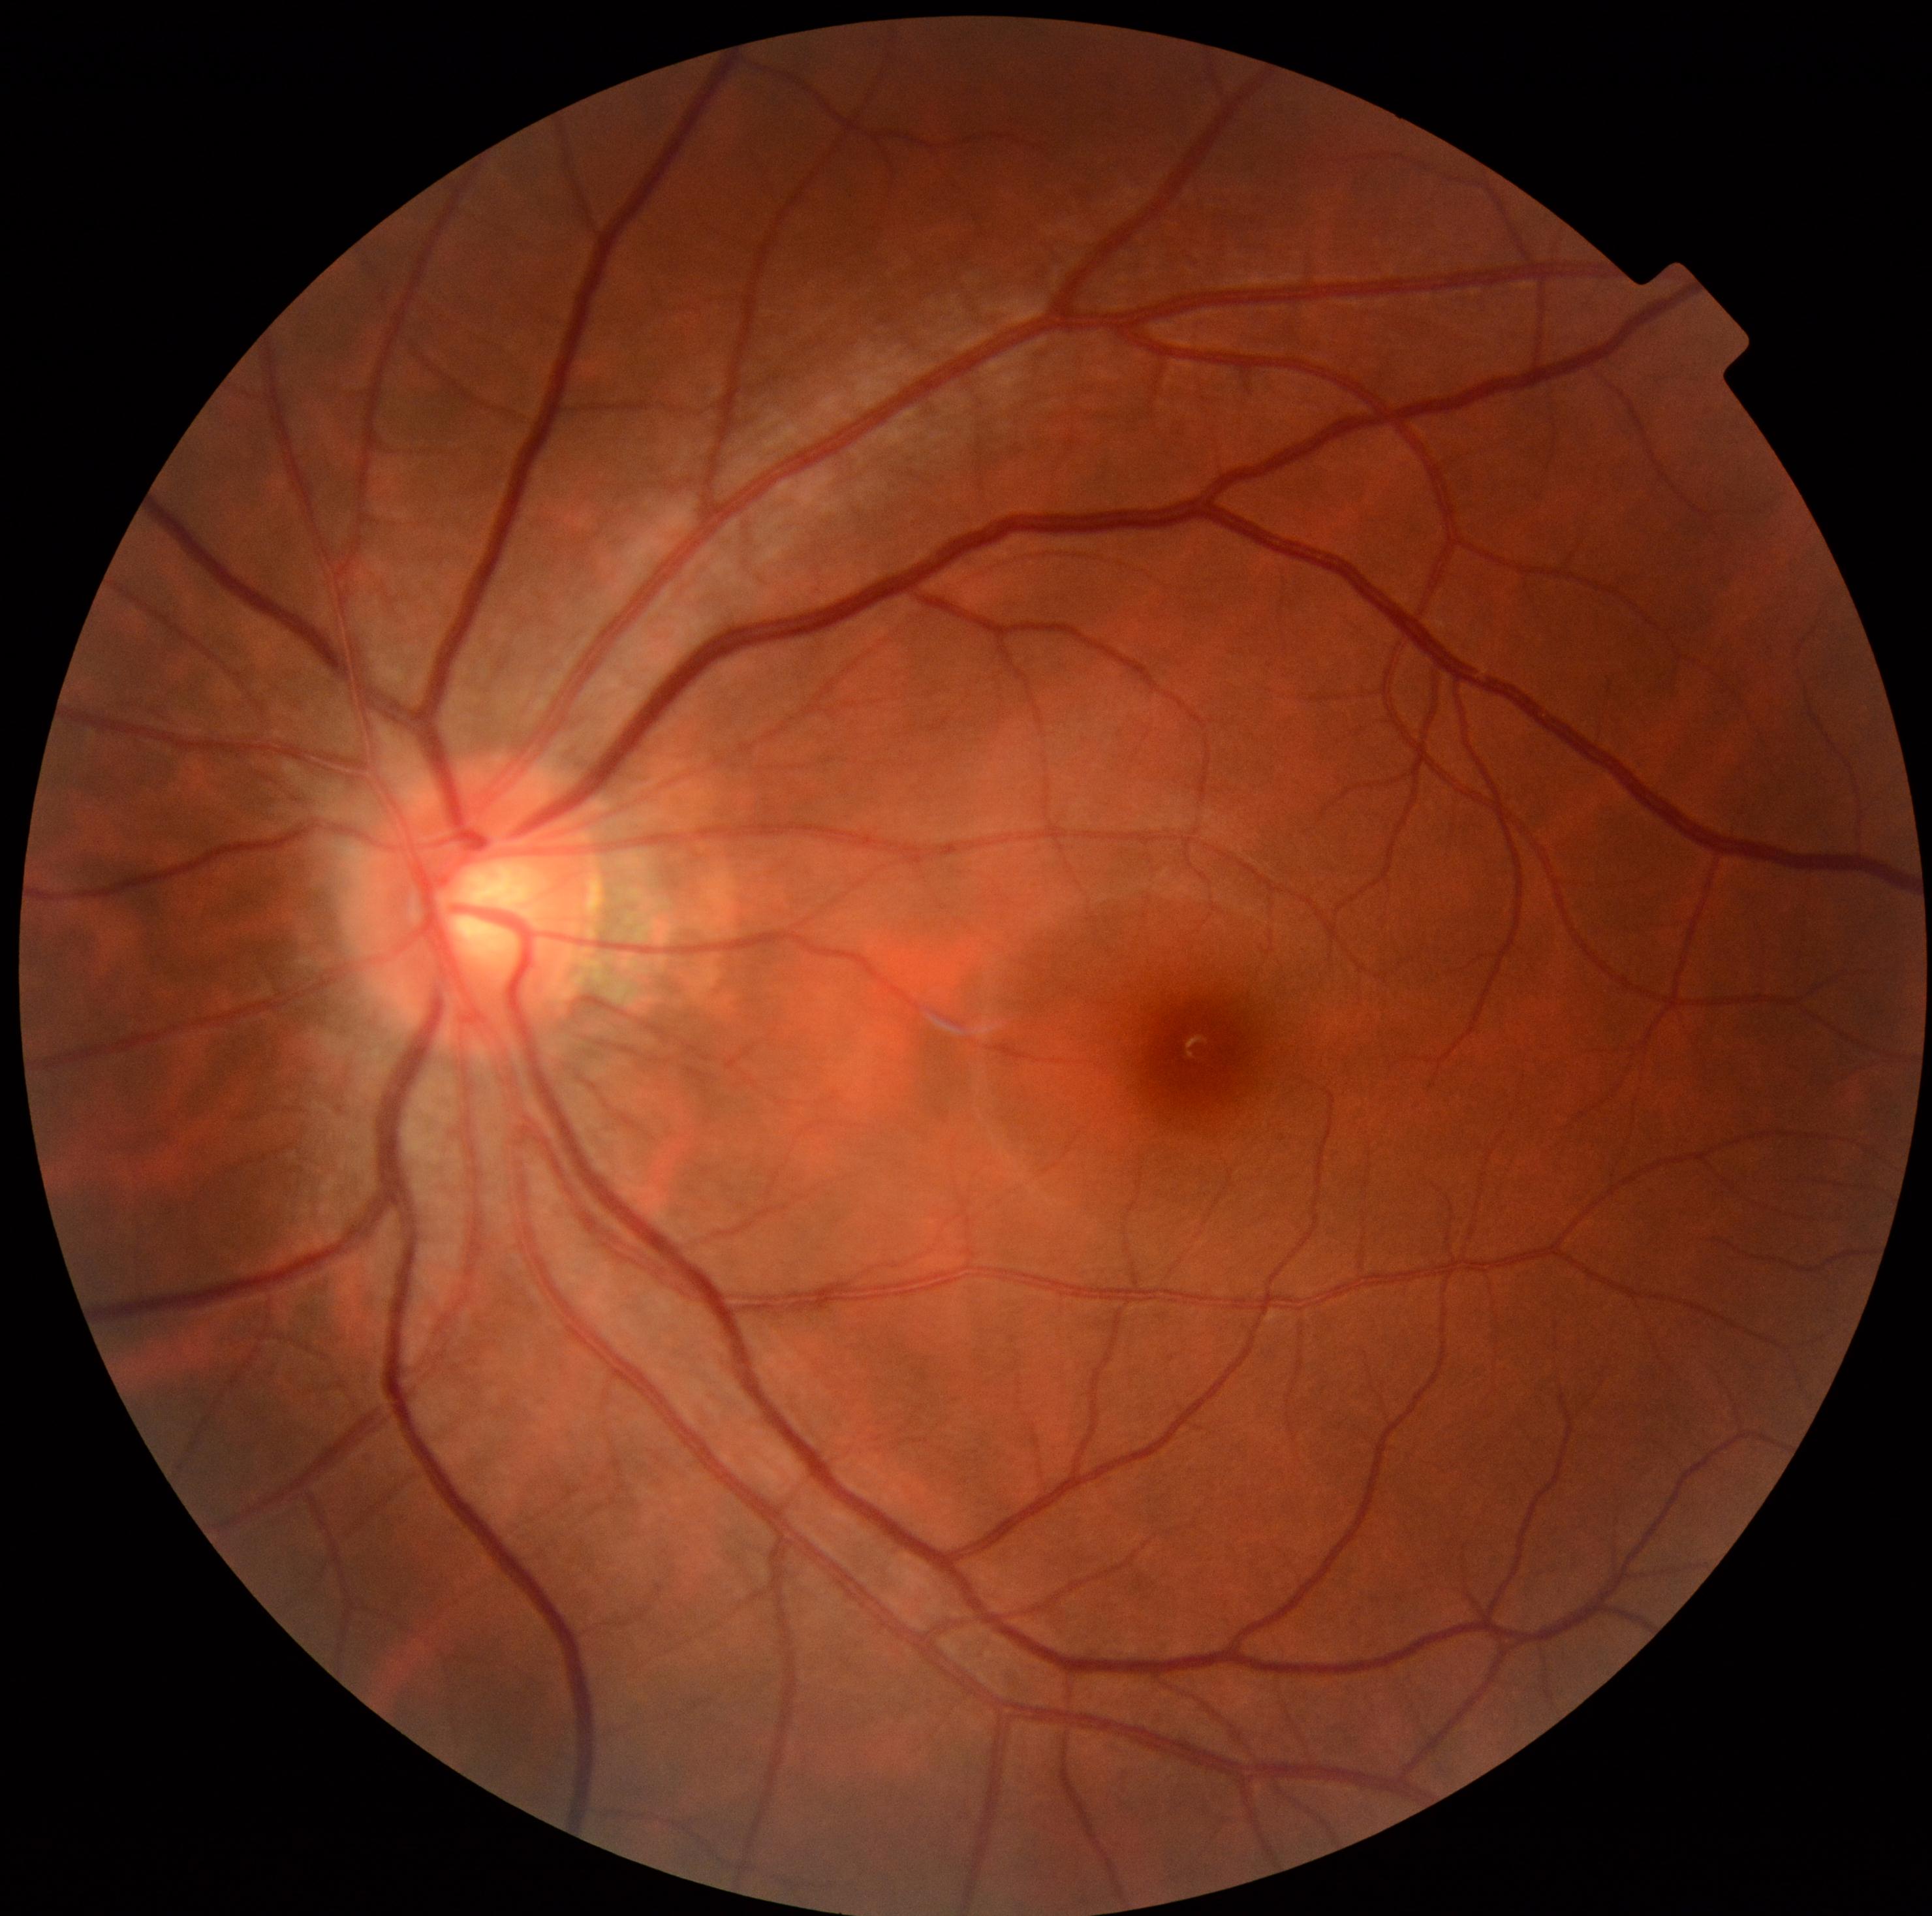 diabetic retinopathy (DR) = grade 0.